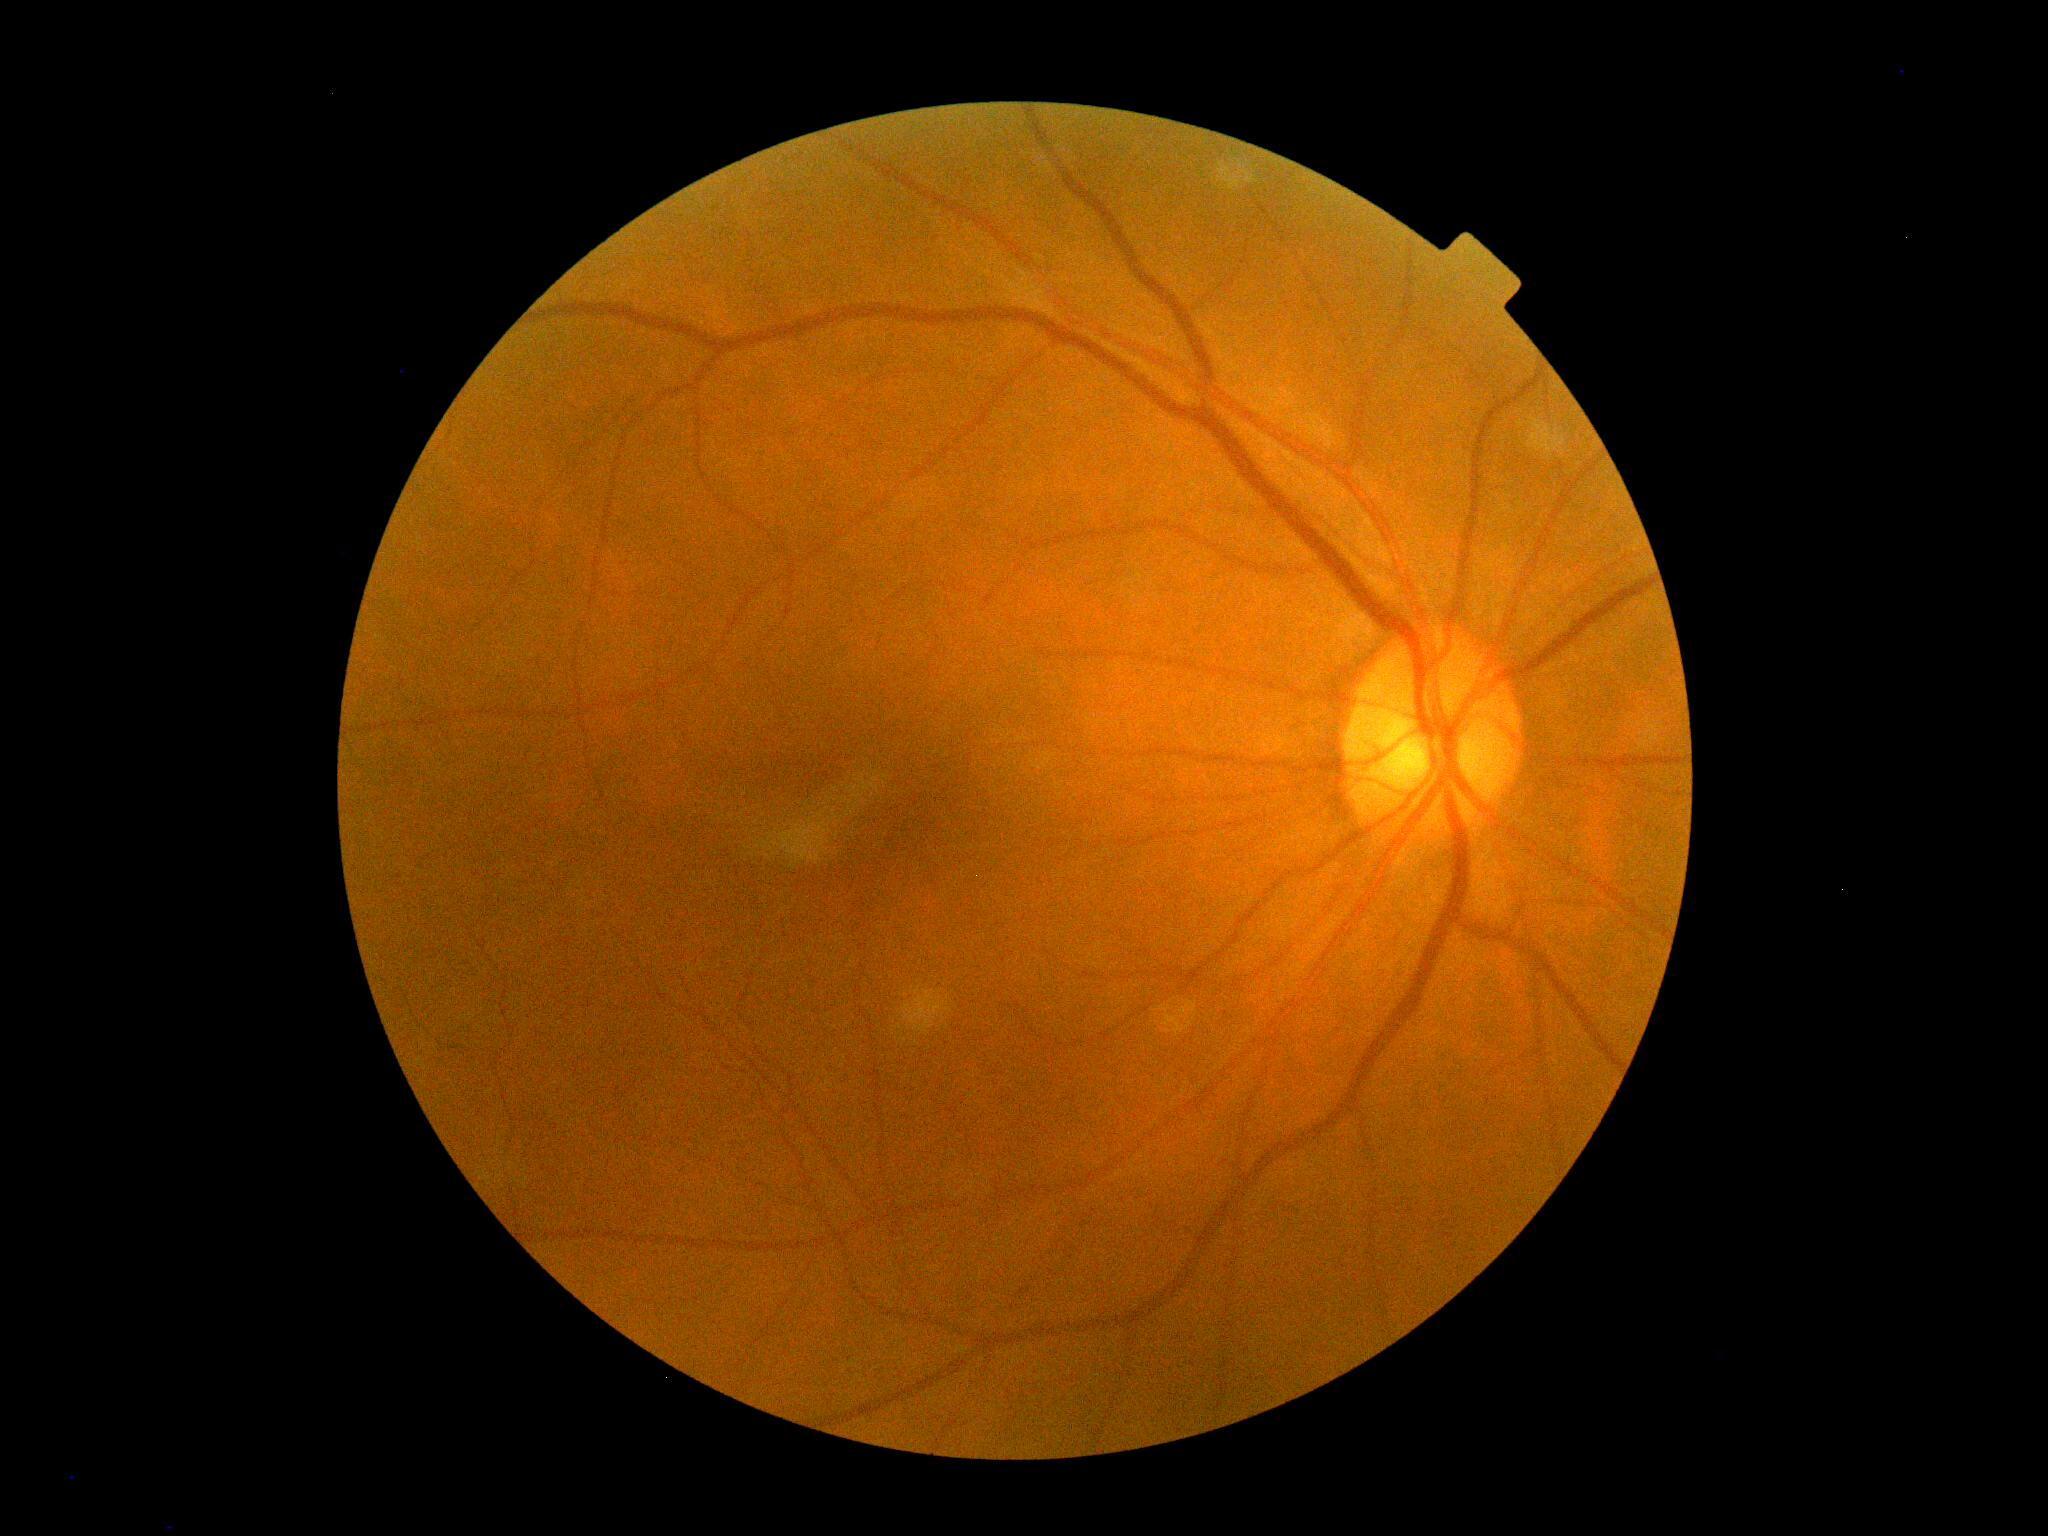

diabetic retinopathy = no apparent retinopathy (grade 0)